45 degree fundus photograph: 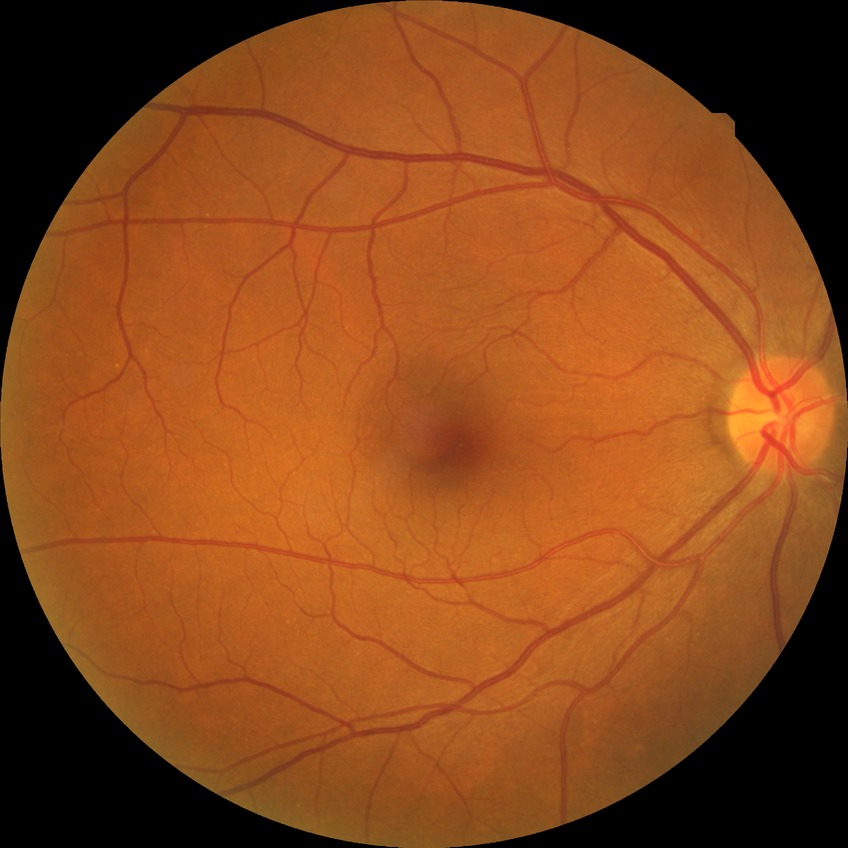

Diabetic retinopathy (DR): NDR (no diabetic retinopathy).